Color fundus photograph: 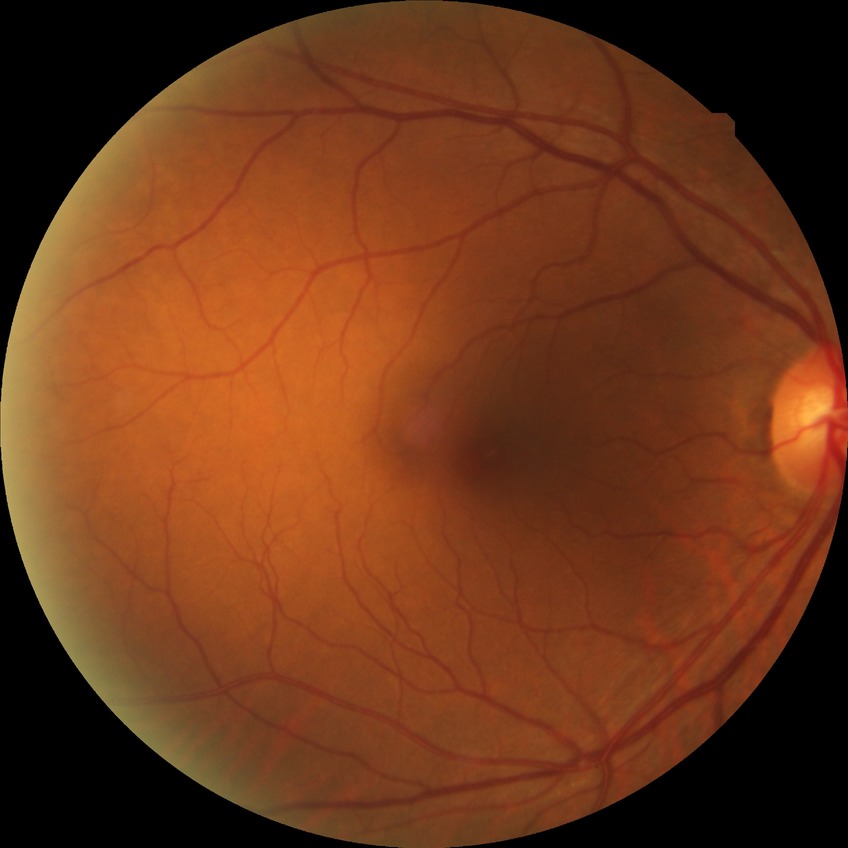
diabetic retinopathy (DR): no diabetic retinopathy (NDR).